Davis DR grading — 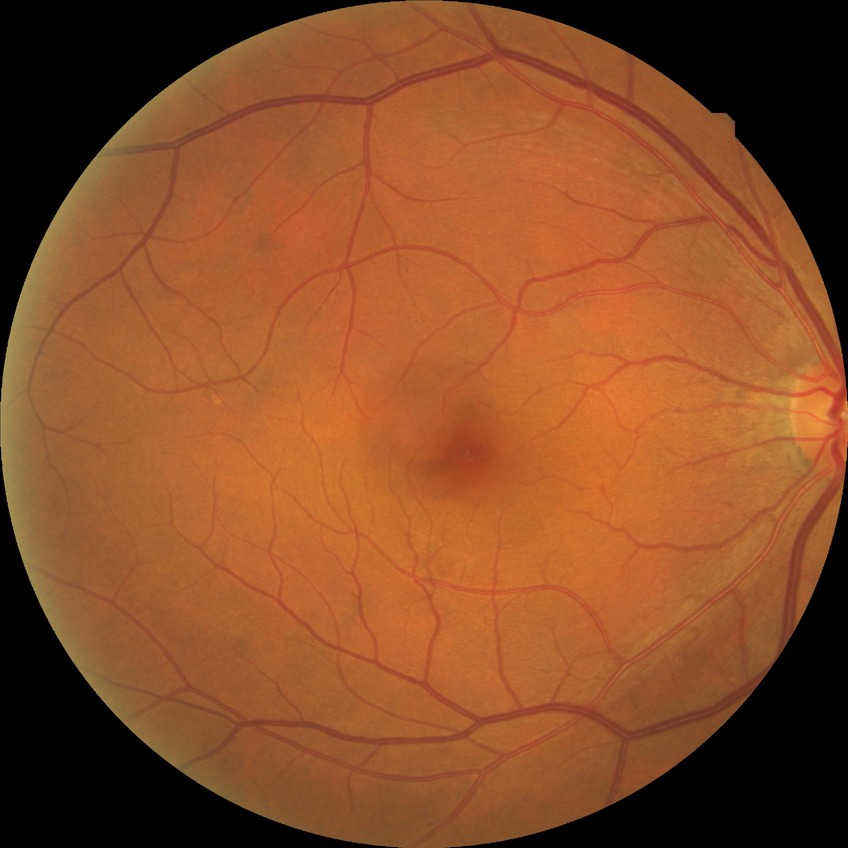

Modified Davis grade is NDR.